45° FOV · 2352x1568px · fundus photo.
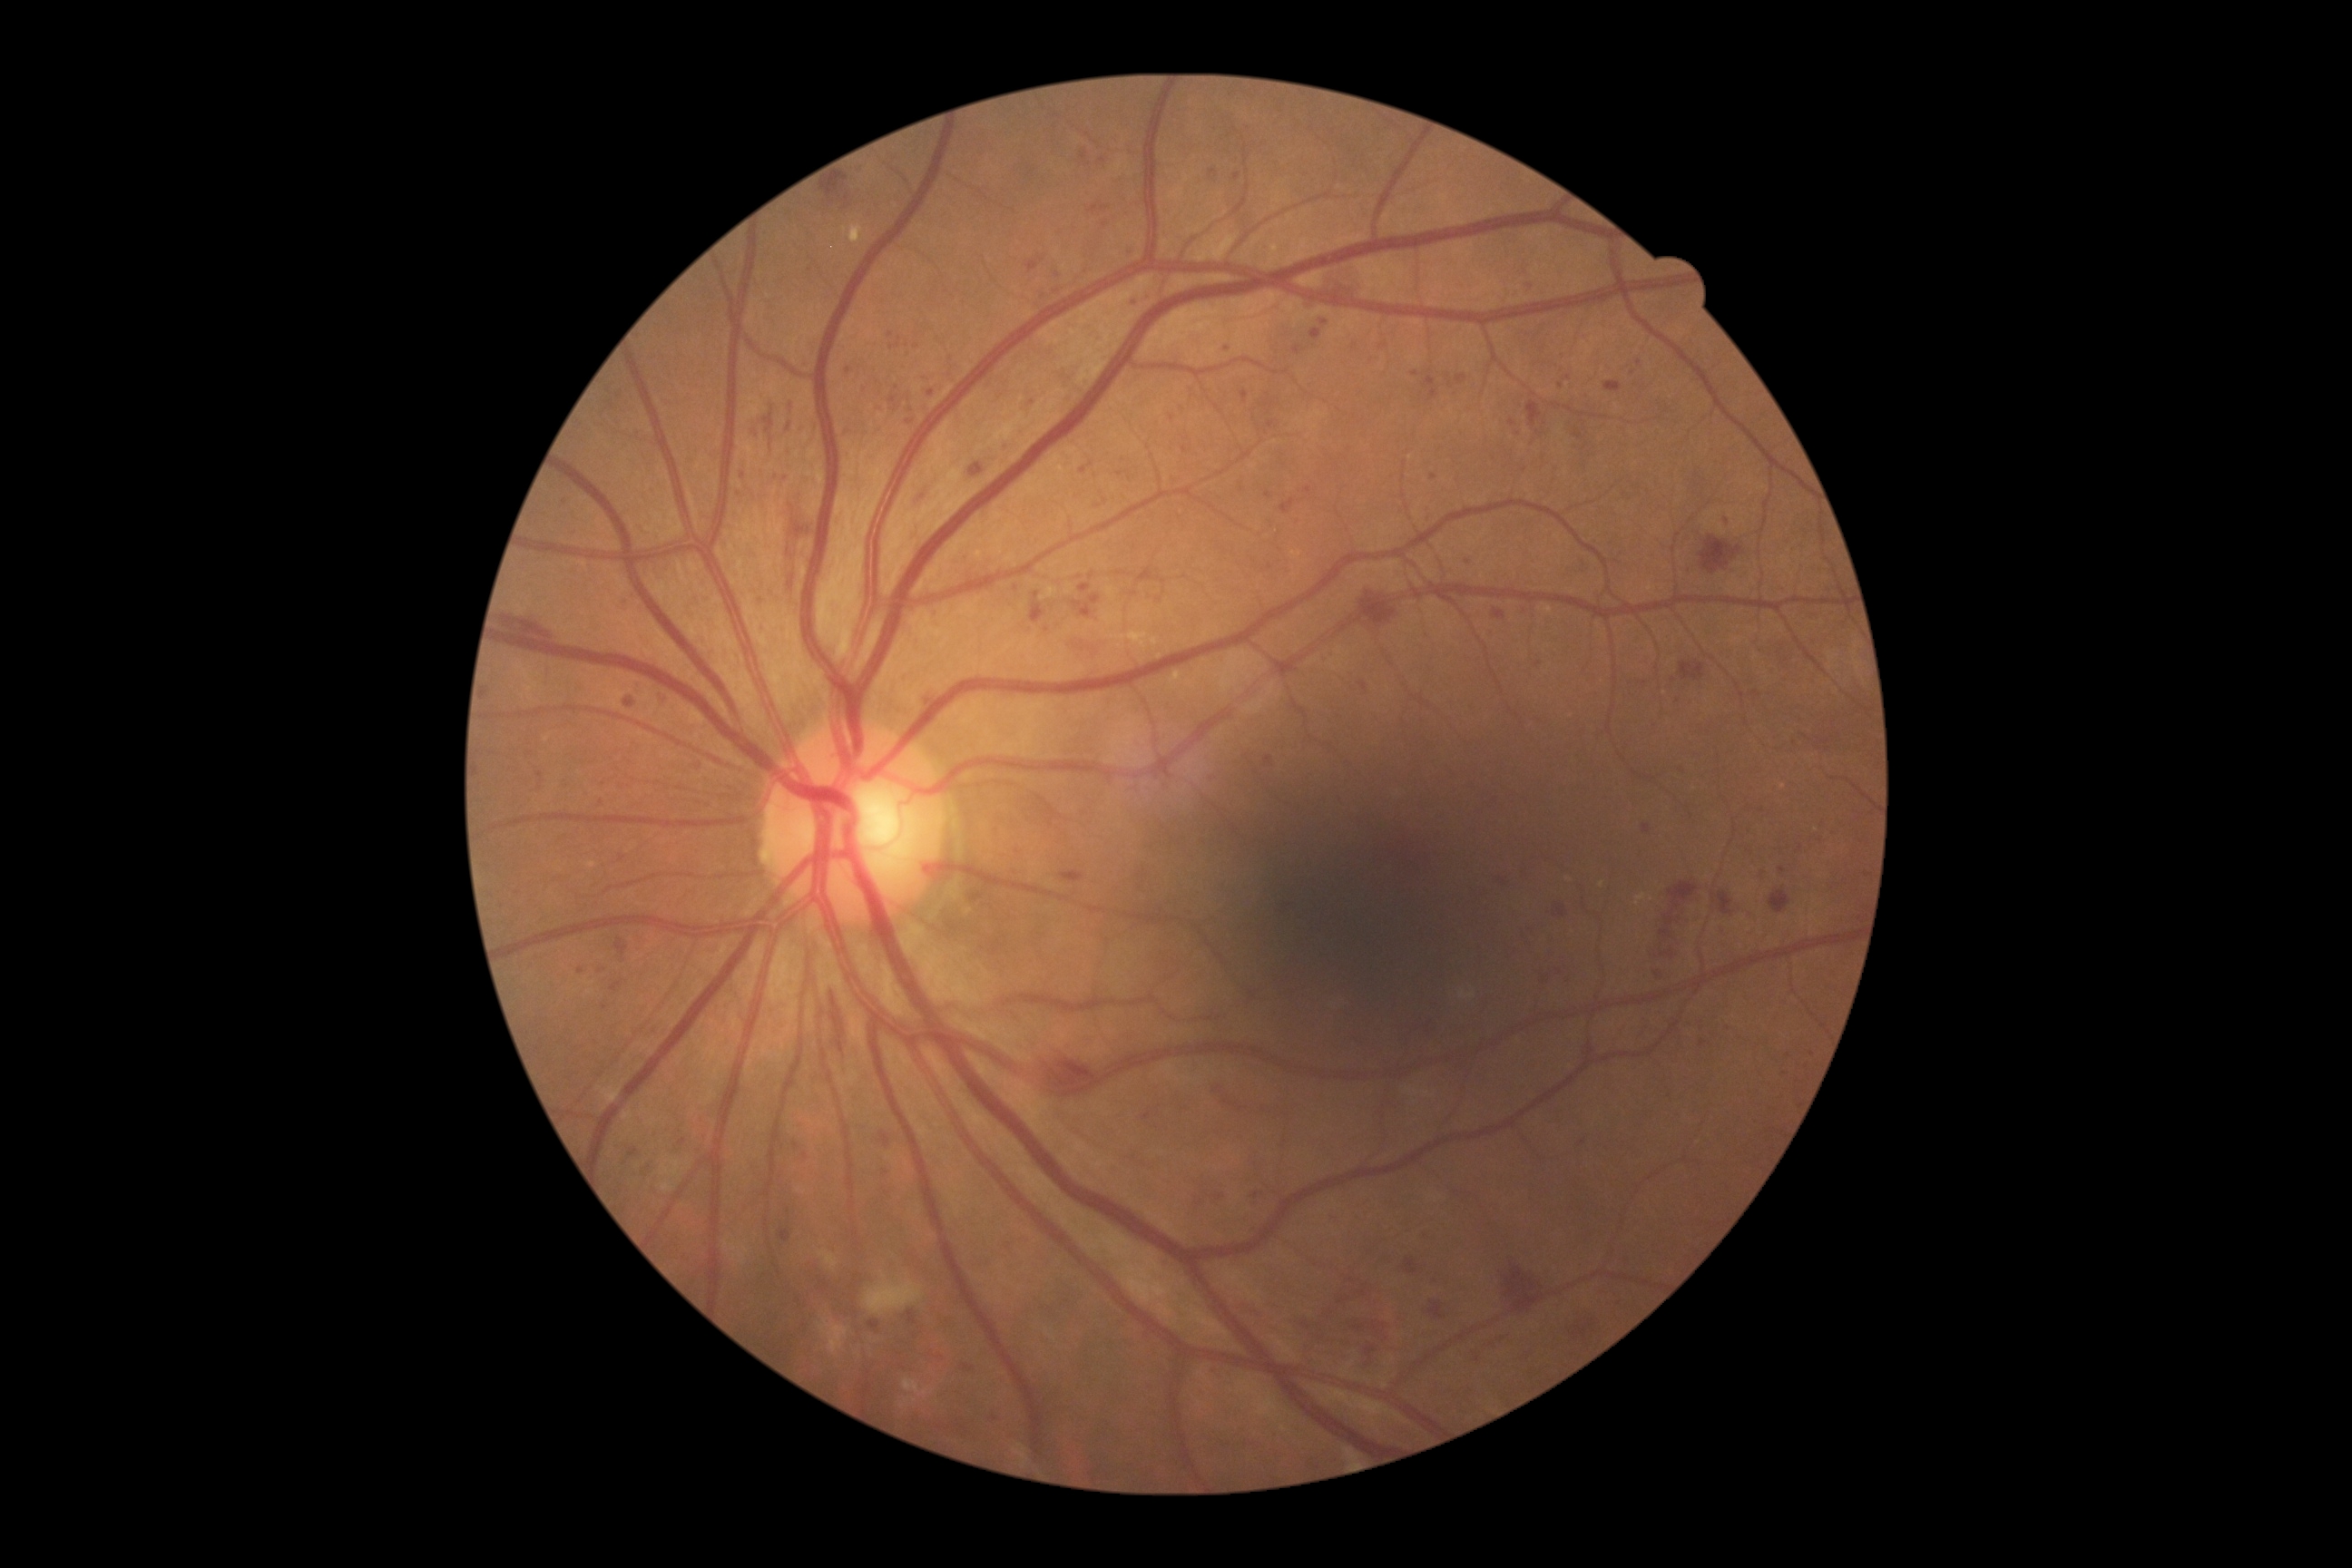 Diabetic retinopathy (DR): 3/4. Microaneurysms (MAs) are present, including at box(1721, 928, 1727, 936), box(861, 382, 870, 393), box(629, 594, 636, 602), box(622, 603, 627, 612), box(616, 939, 629, 956), box(1142, 1113, 1152, 1121), box(1090, 594, 1101, 605), box(761, 631, 769, 634), box(756, 598, 769, 609), box(847, 431, 858, 438). Small MAs near {"x": 1218, "y": 1090}, {"x": 1518, "y": 435}, {"x": 1228, "y": 349}, {"x": 1041, "y": 260}, {"x": 743, "y": 476}, {"x": 938, "y": 613}, {"x": 1375, "y": 1328}, {"x": 682, "y": 1142}.